Without pupil dilation · 848 by 848 pixels: 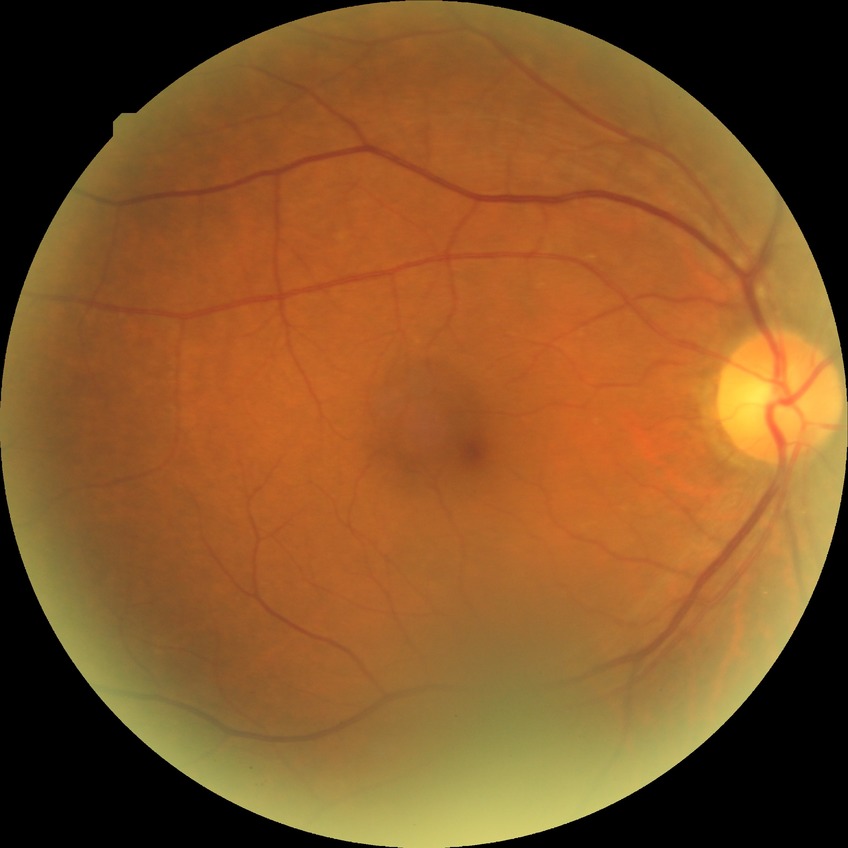

Modified Davis grade: NDR. No signs of diabetic retinopathy.